Acquired on the Clarity RetCam 3; infant wide-field retinal image
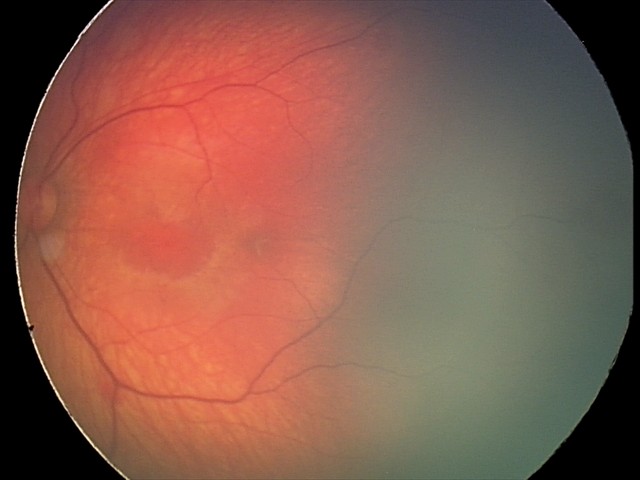 Diagnosis: retinal hemorrhages.